130° field of view (Clarity RetCam 3). 640 by 480 pixels. Wide-field fundus photograph of an infant — 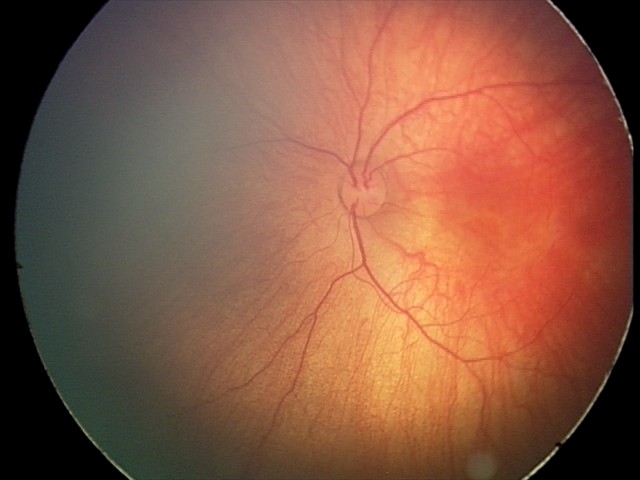
Diagnosis from this screening exam: retinal hemorrhages.